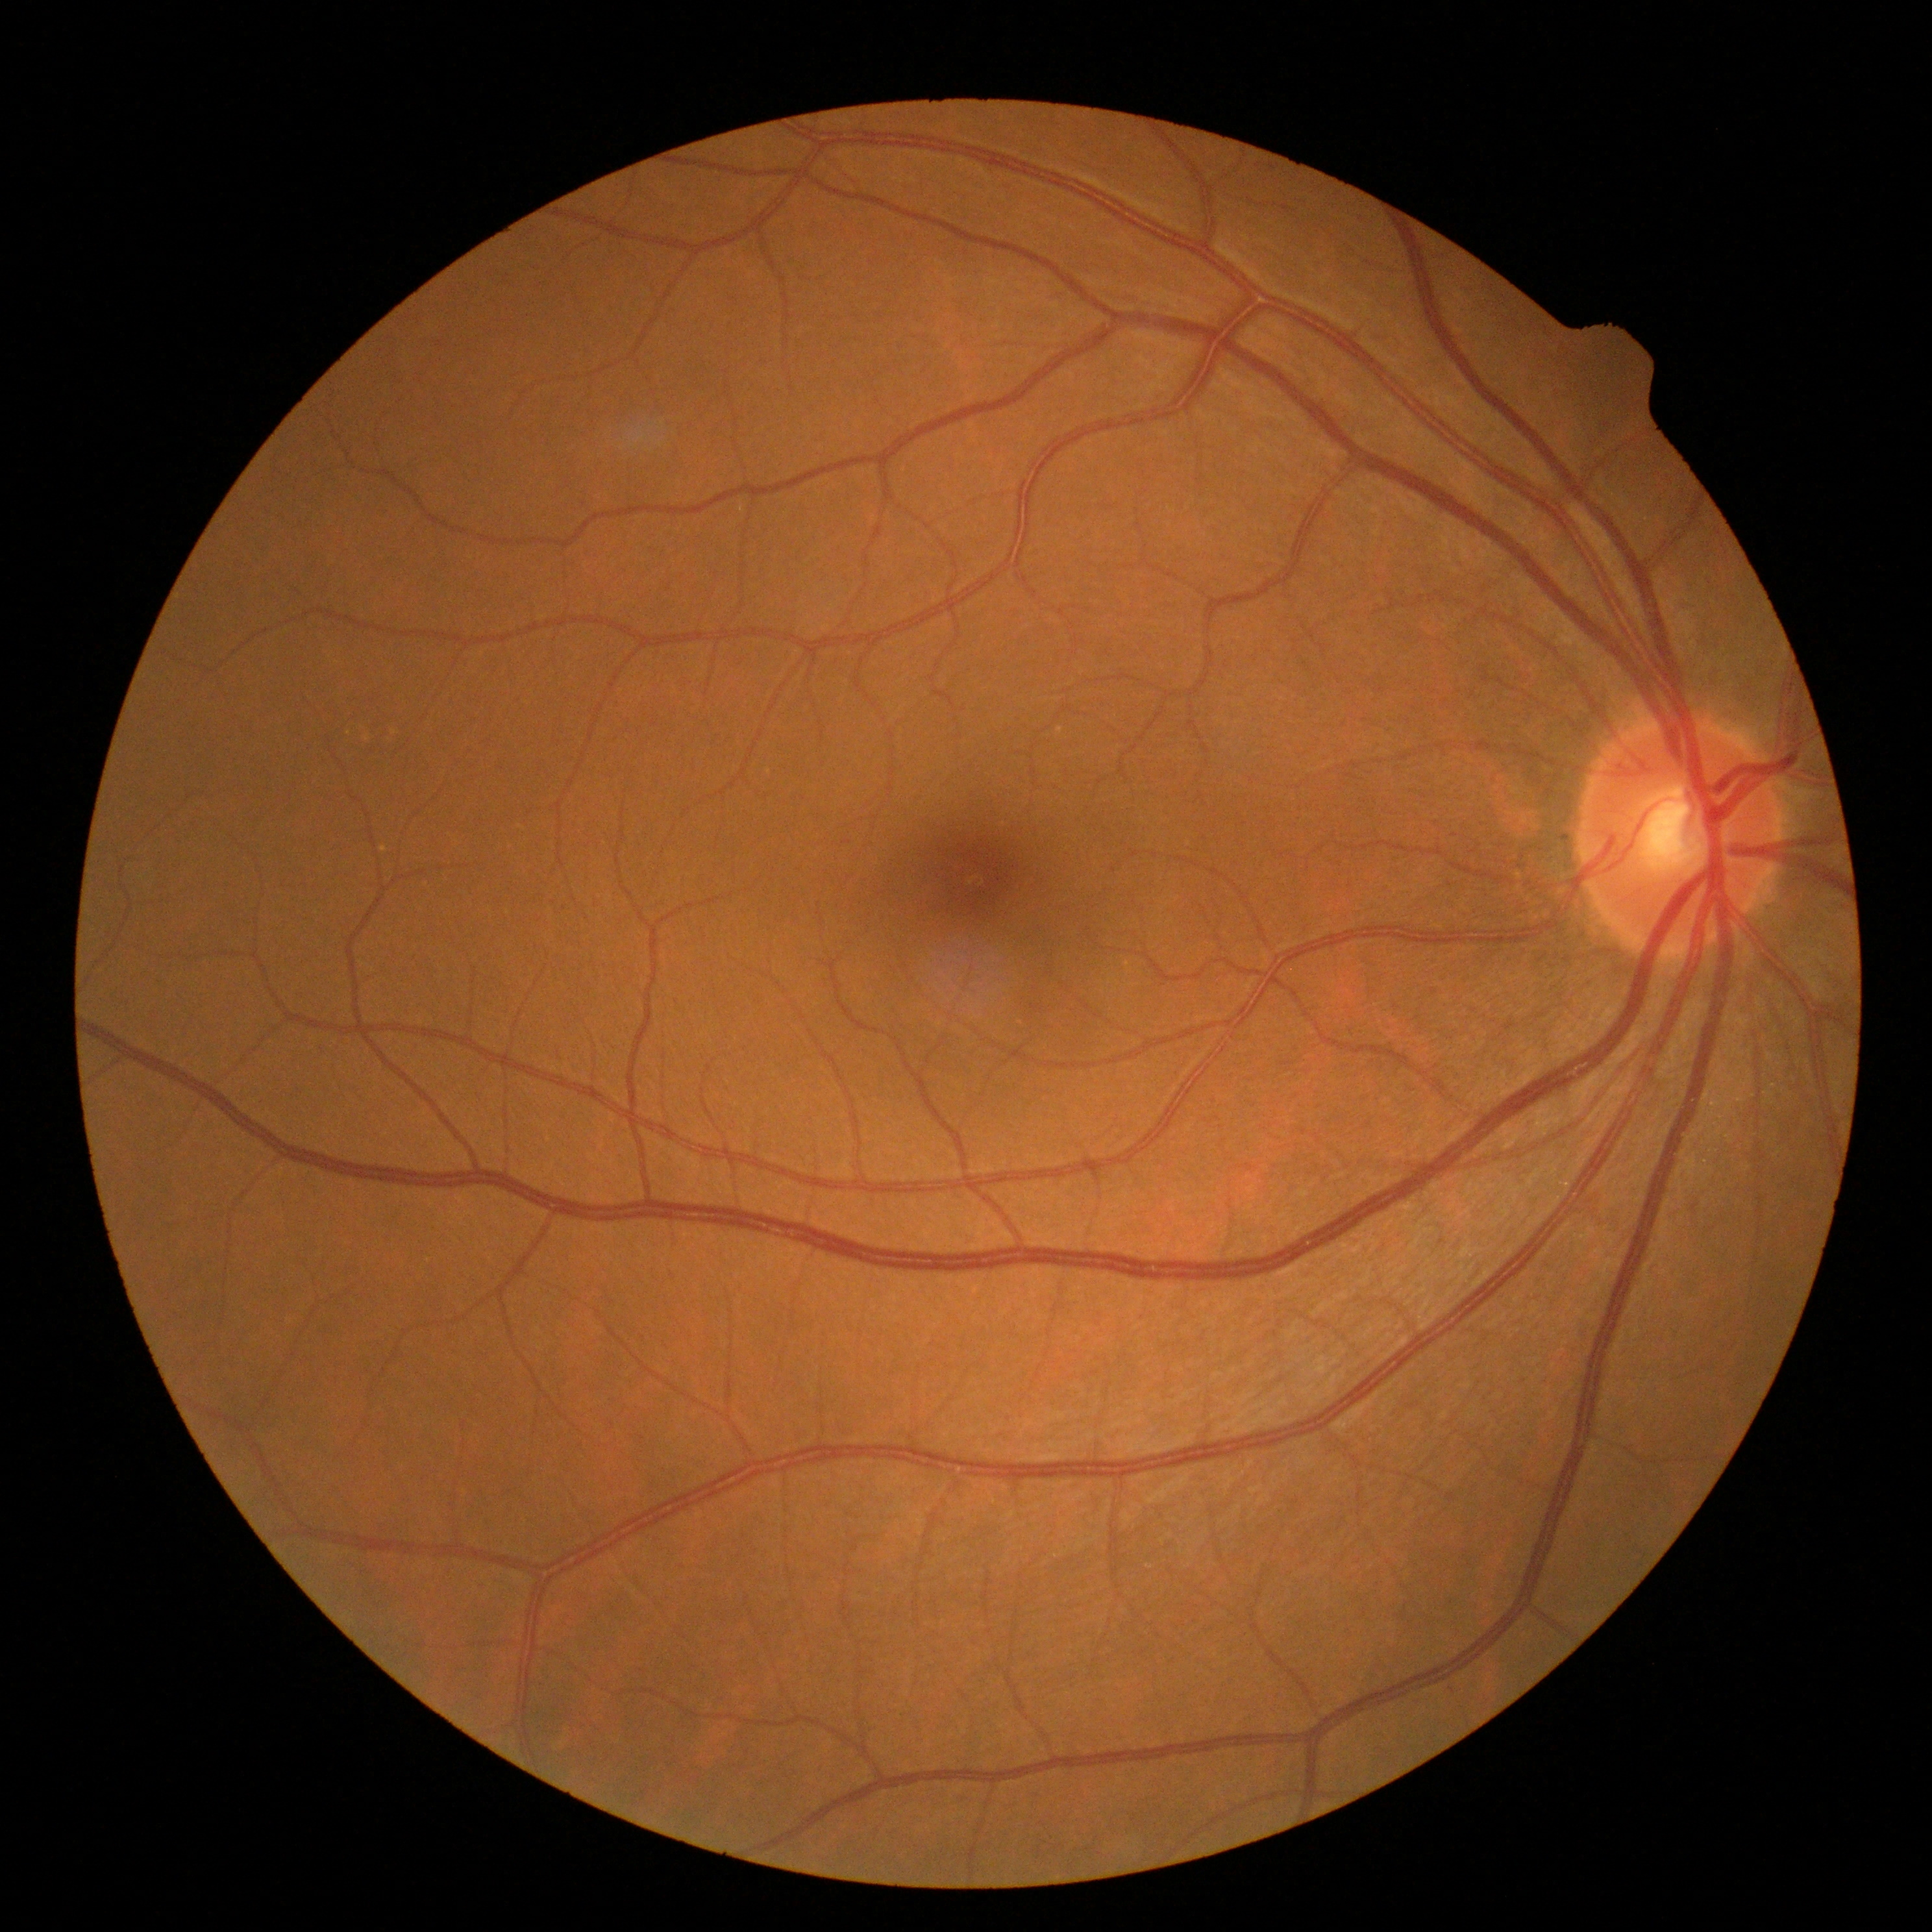

diabetic retinopathy (DR) = no apparent diabetic retinopathy (grade 0).